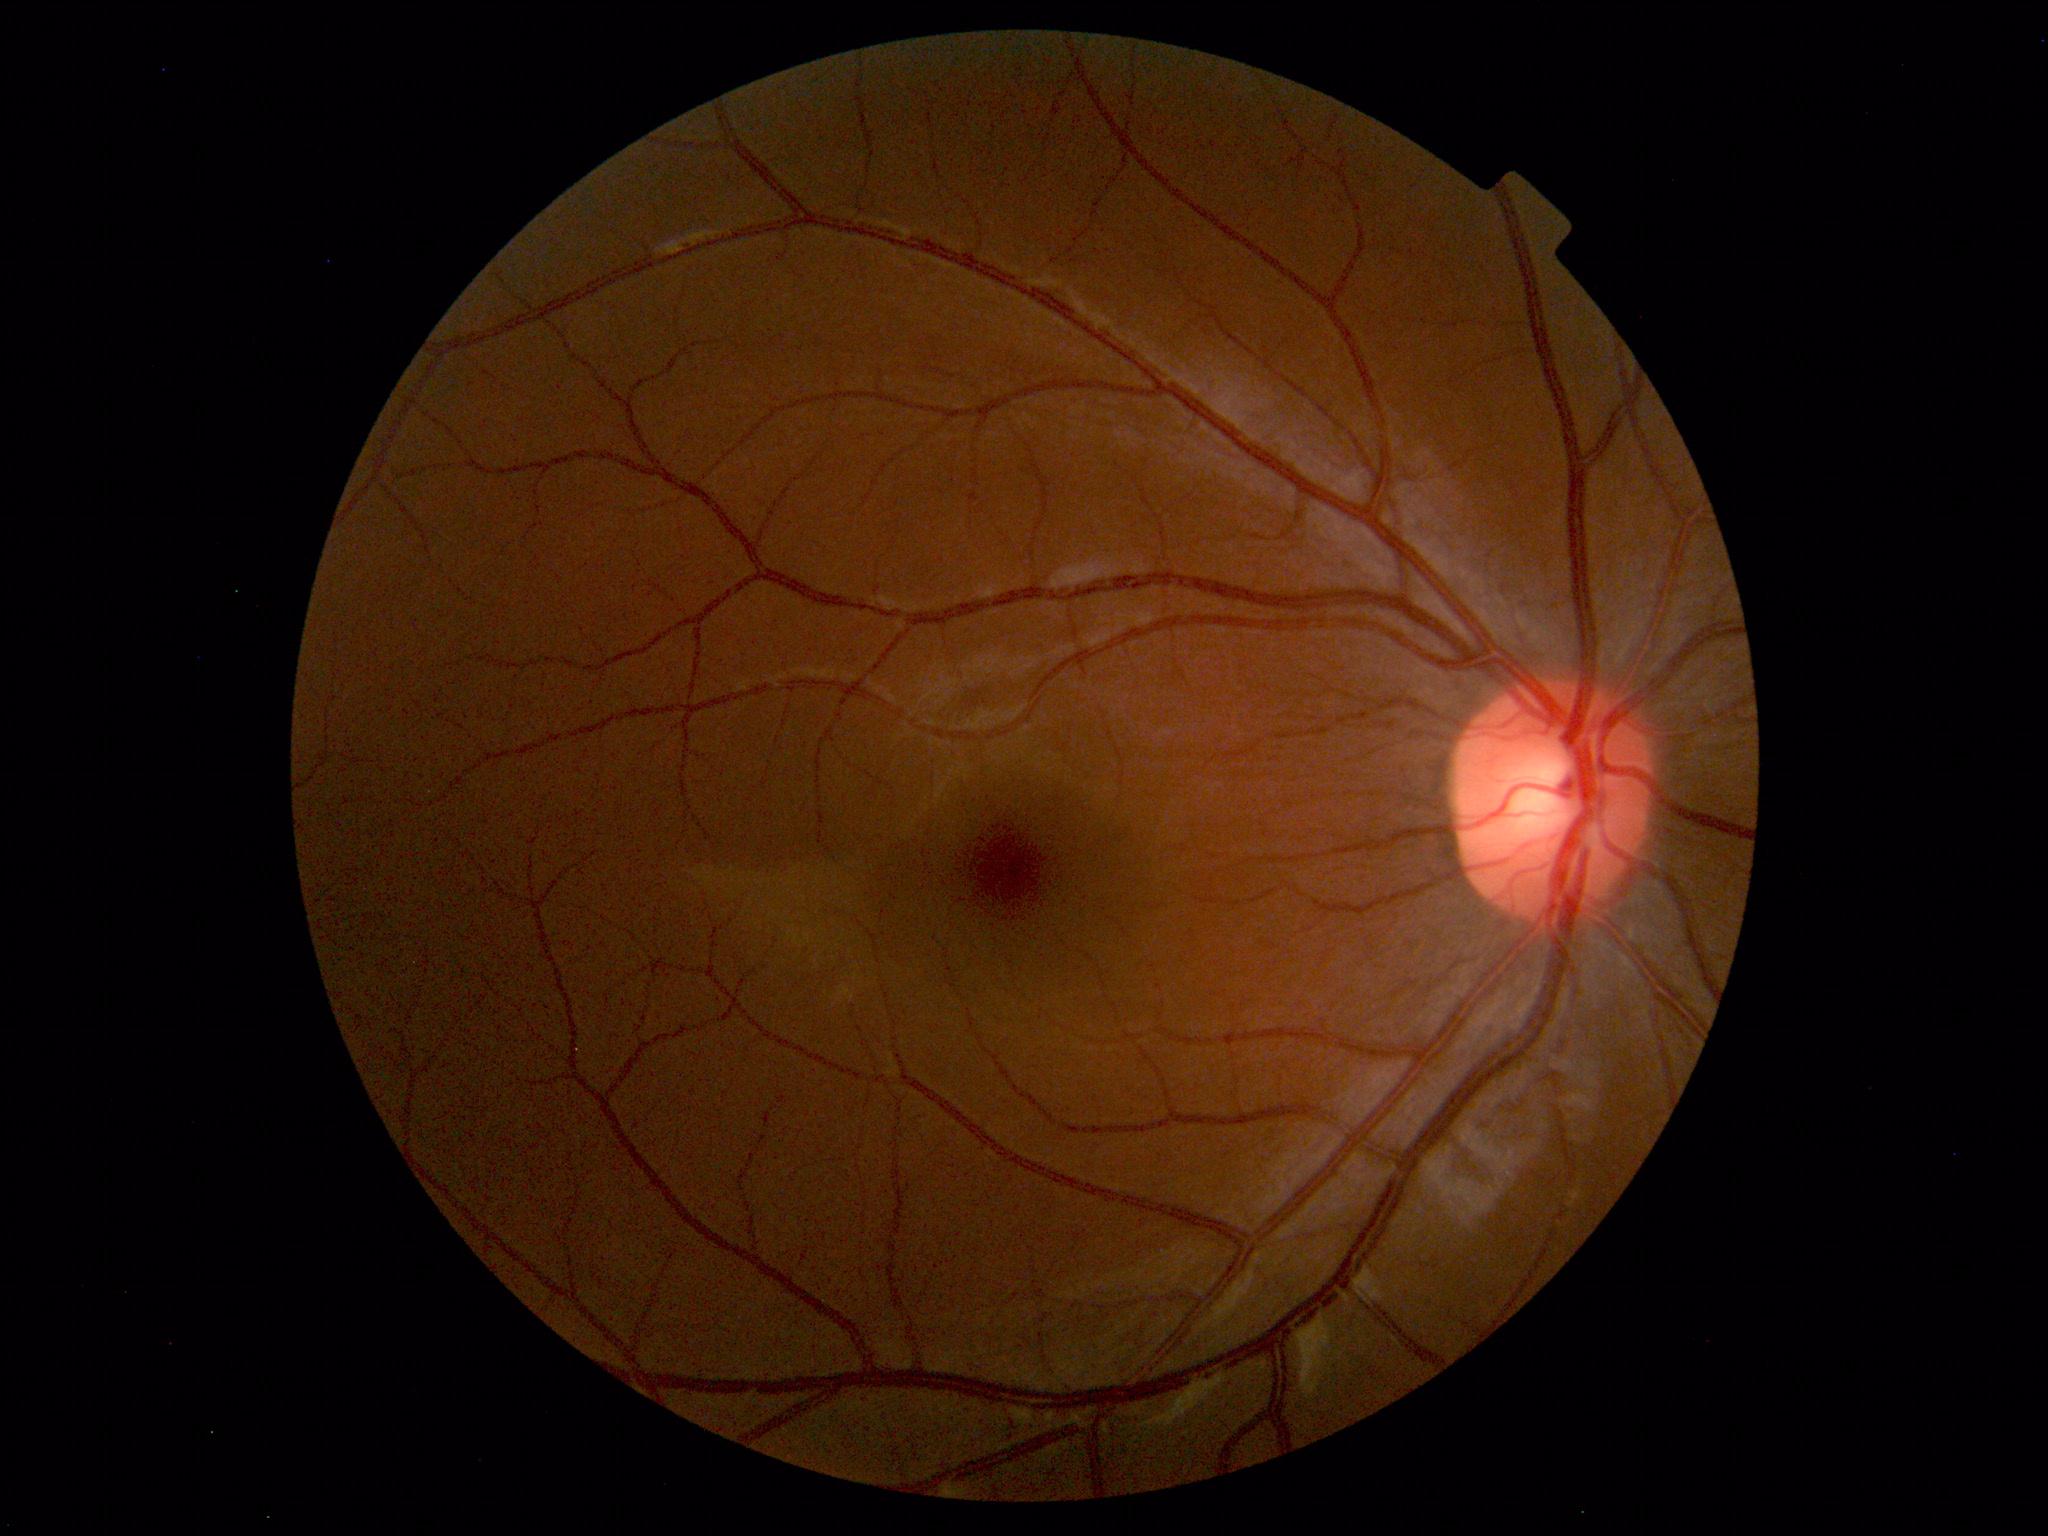

Normal color fundus photograph.